848x848, diabetic retinopathy graded by the modified Davis classification.
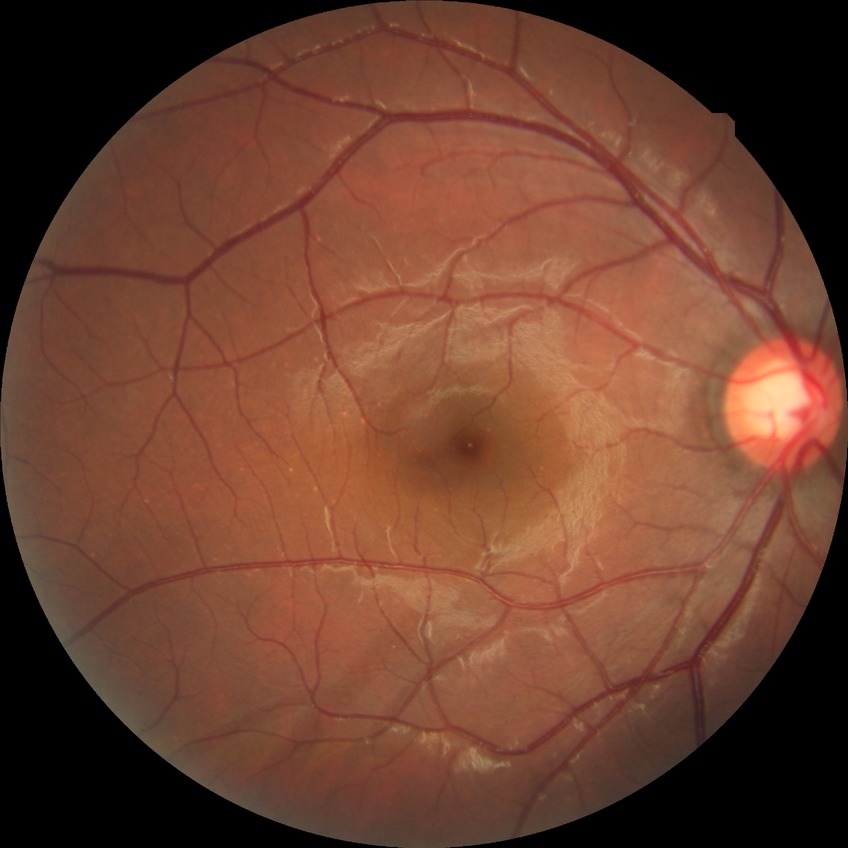 Diabetic retinopathy (DR): no diabetic retinopathy (NDR).